45-degree field of view:
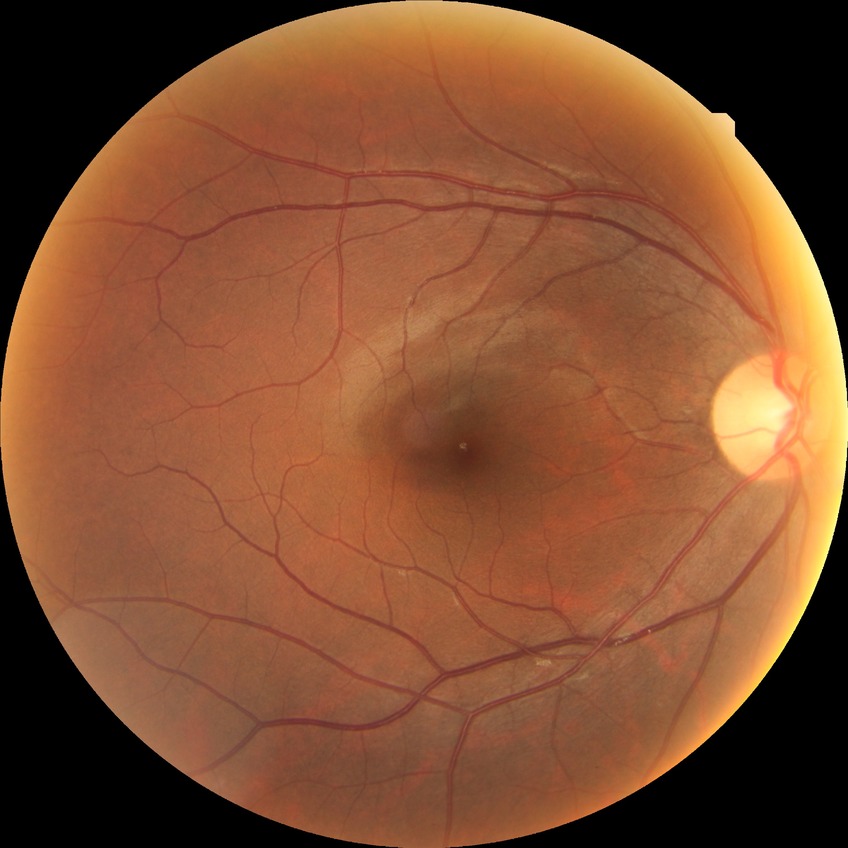 Diabetic retinopathy (DR) is NDR (no diabetic retinopathy).